Fundus image cropped to the optic disc.
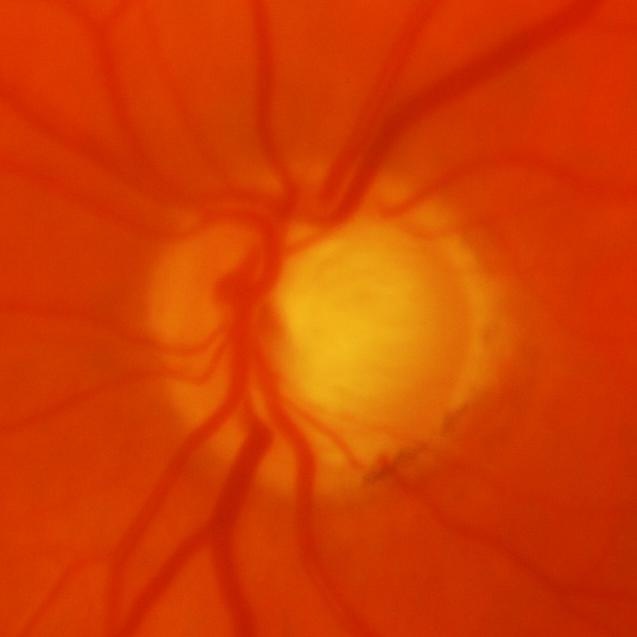
Glaucomatous changes are present. Demonstrates glaucomatous changes.